RetCam wide-field infant fundus image
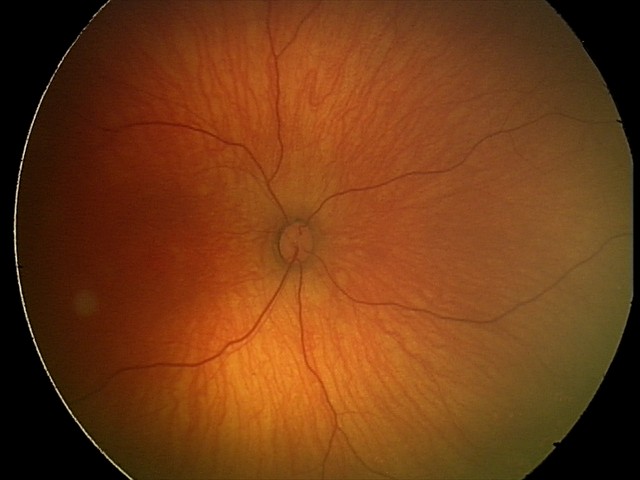

Impression = no pathology identified.